45-degree field of view, 2048 by 1536 pixels
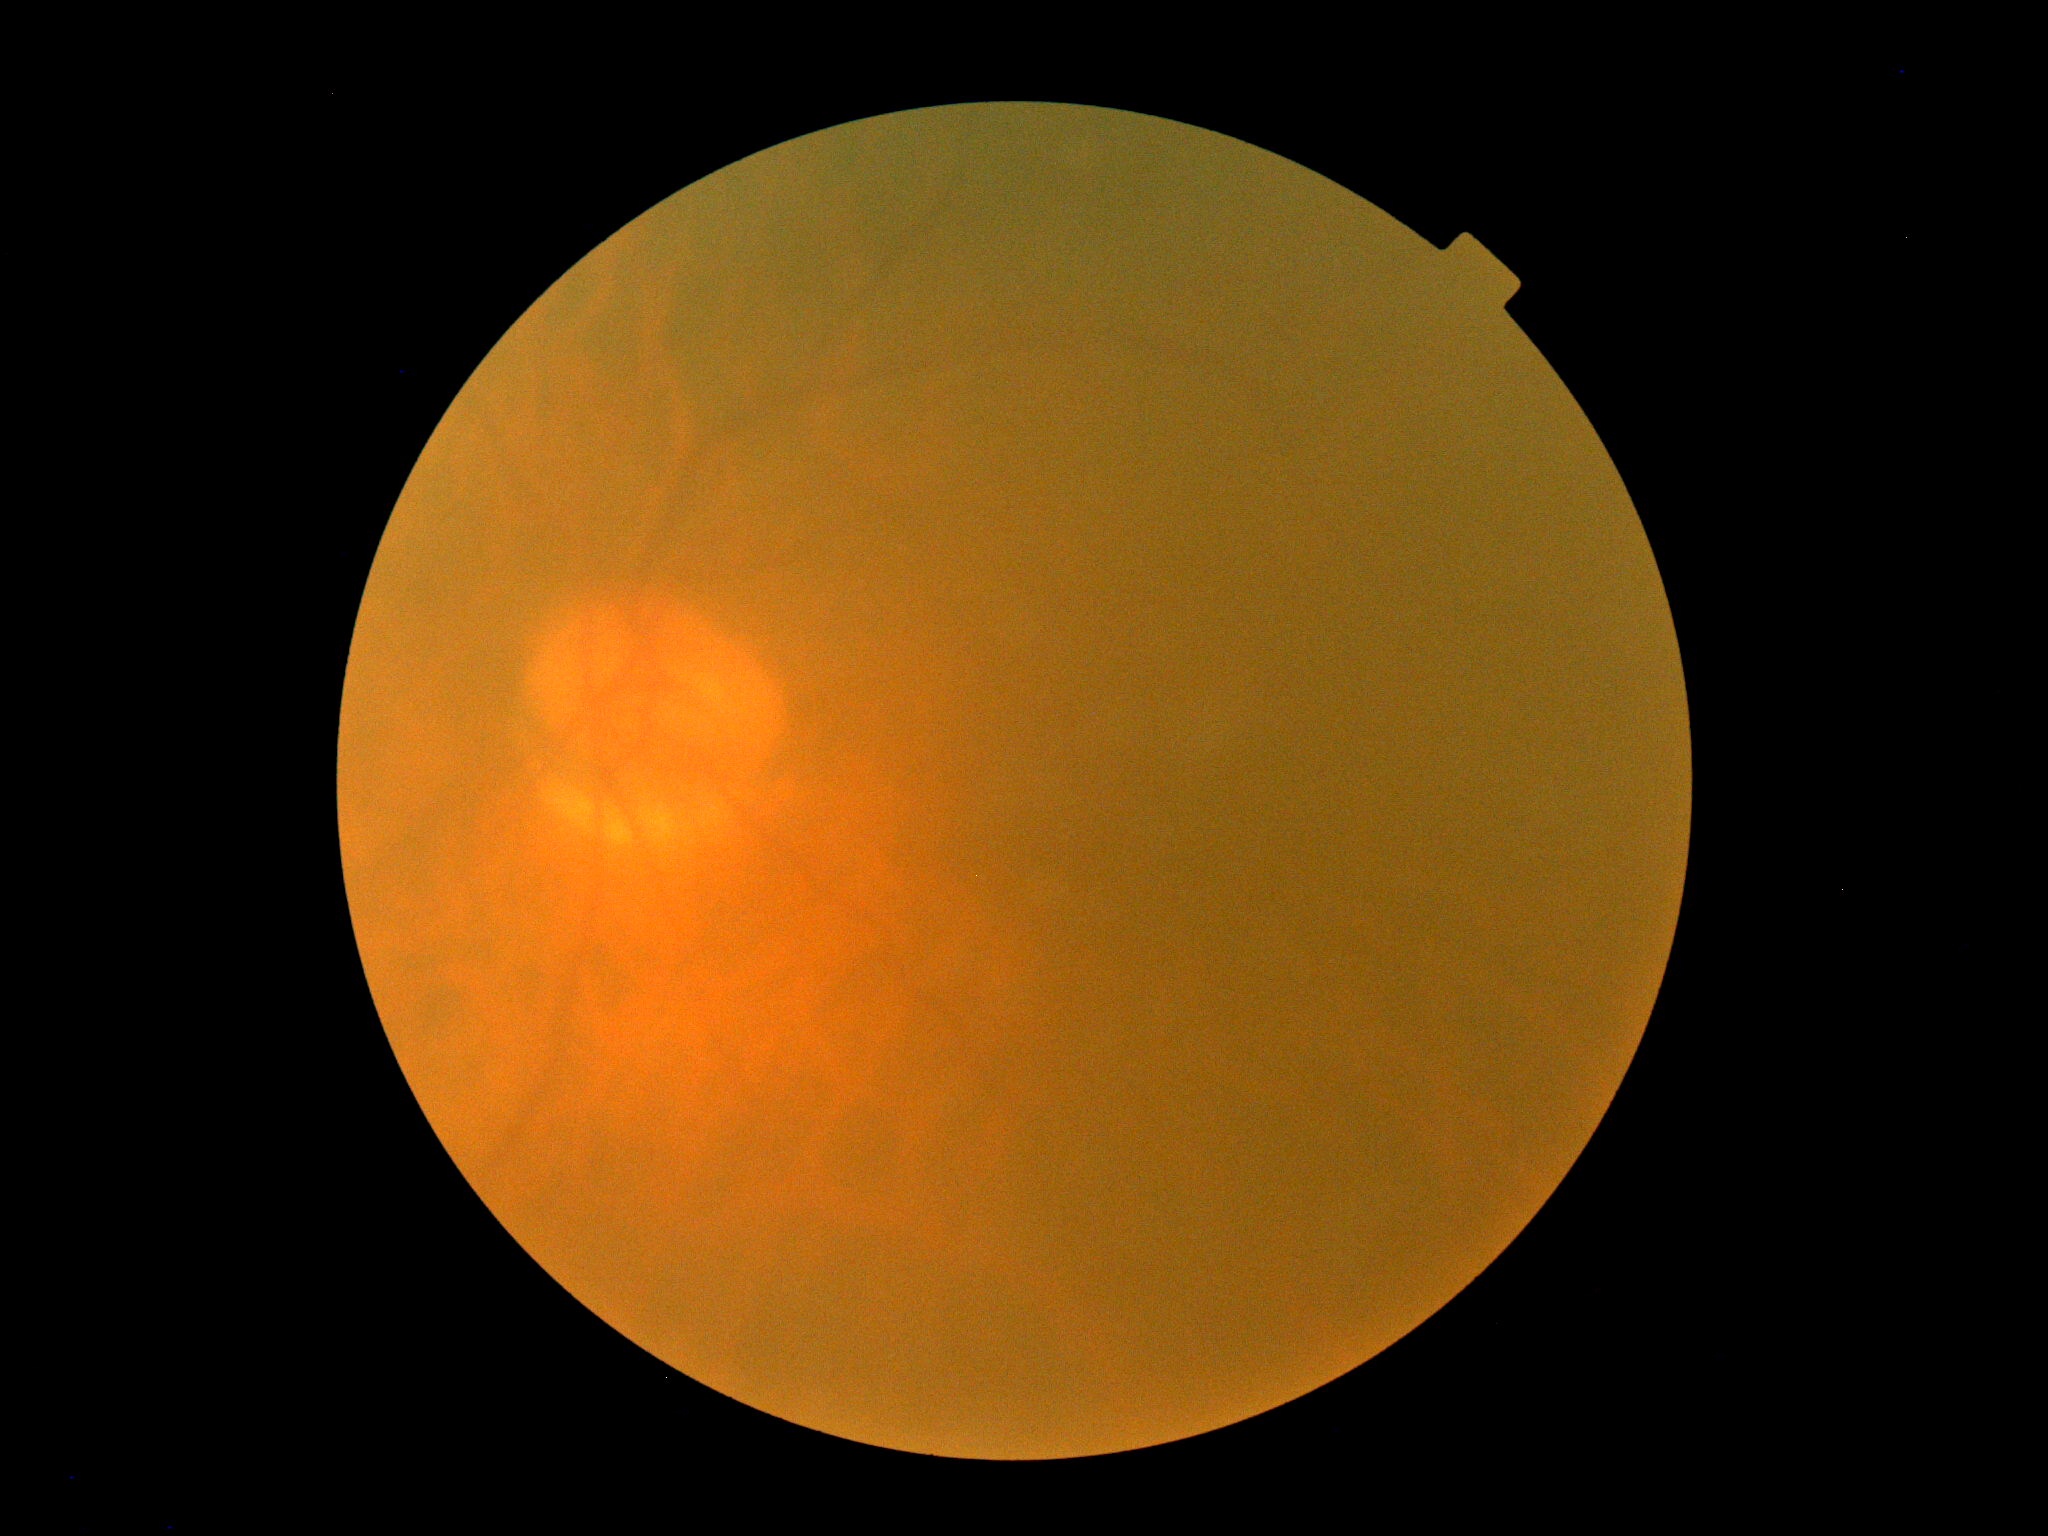

DR is ungradable due to poor image quality.